CFP — 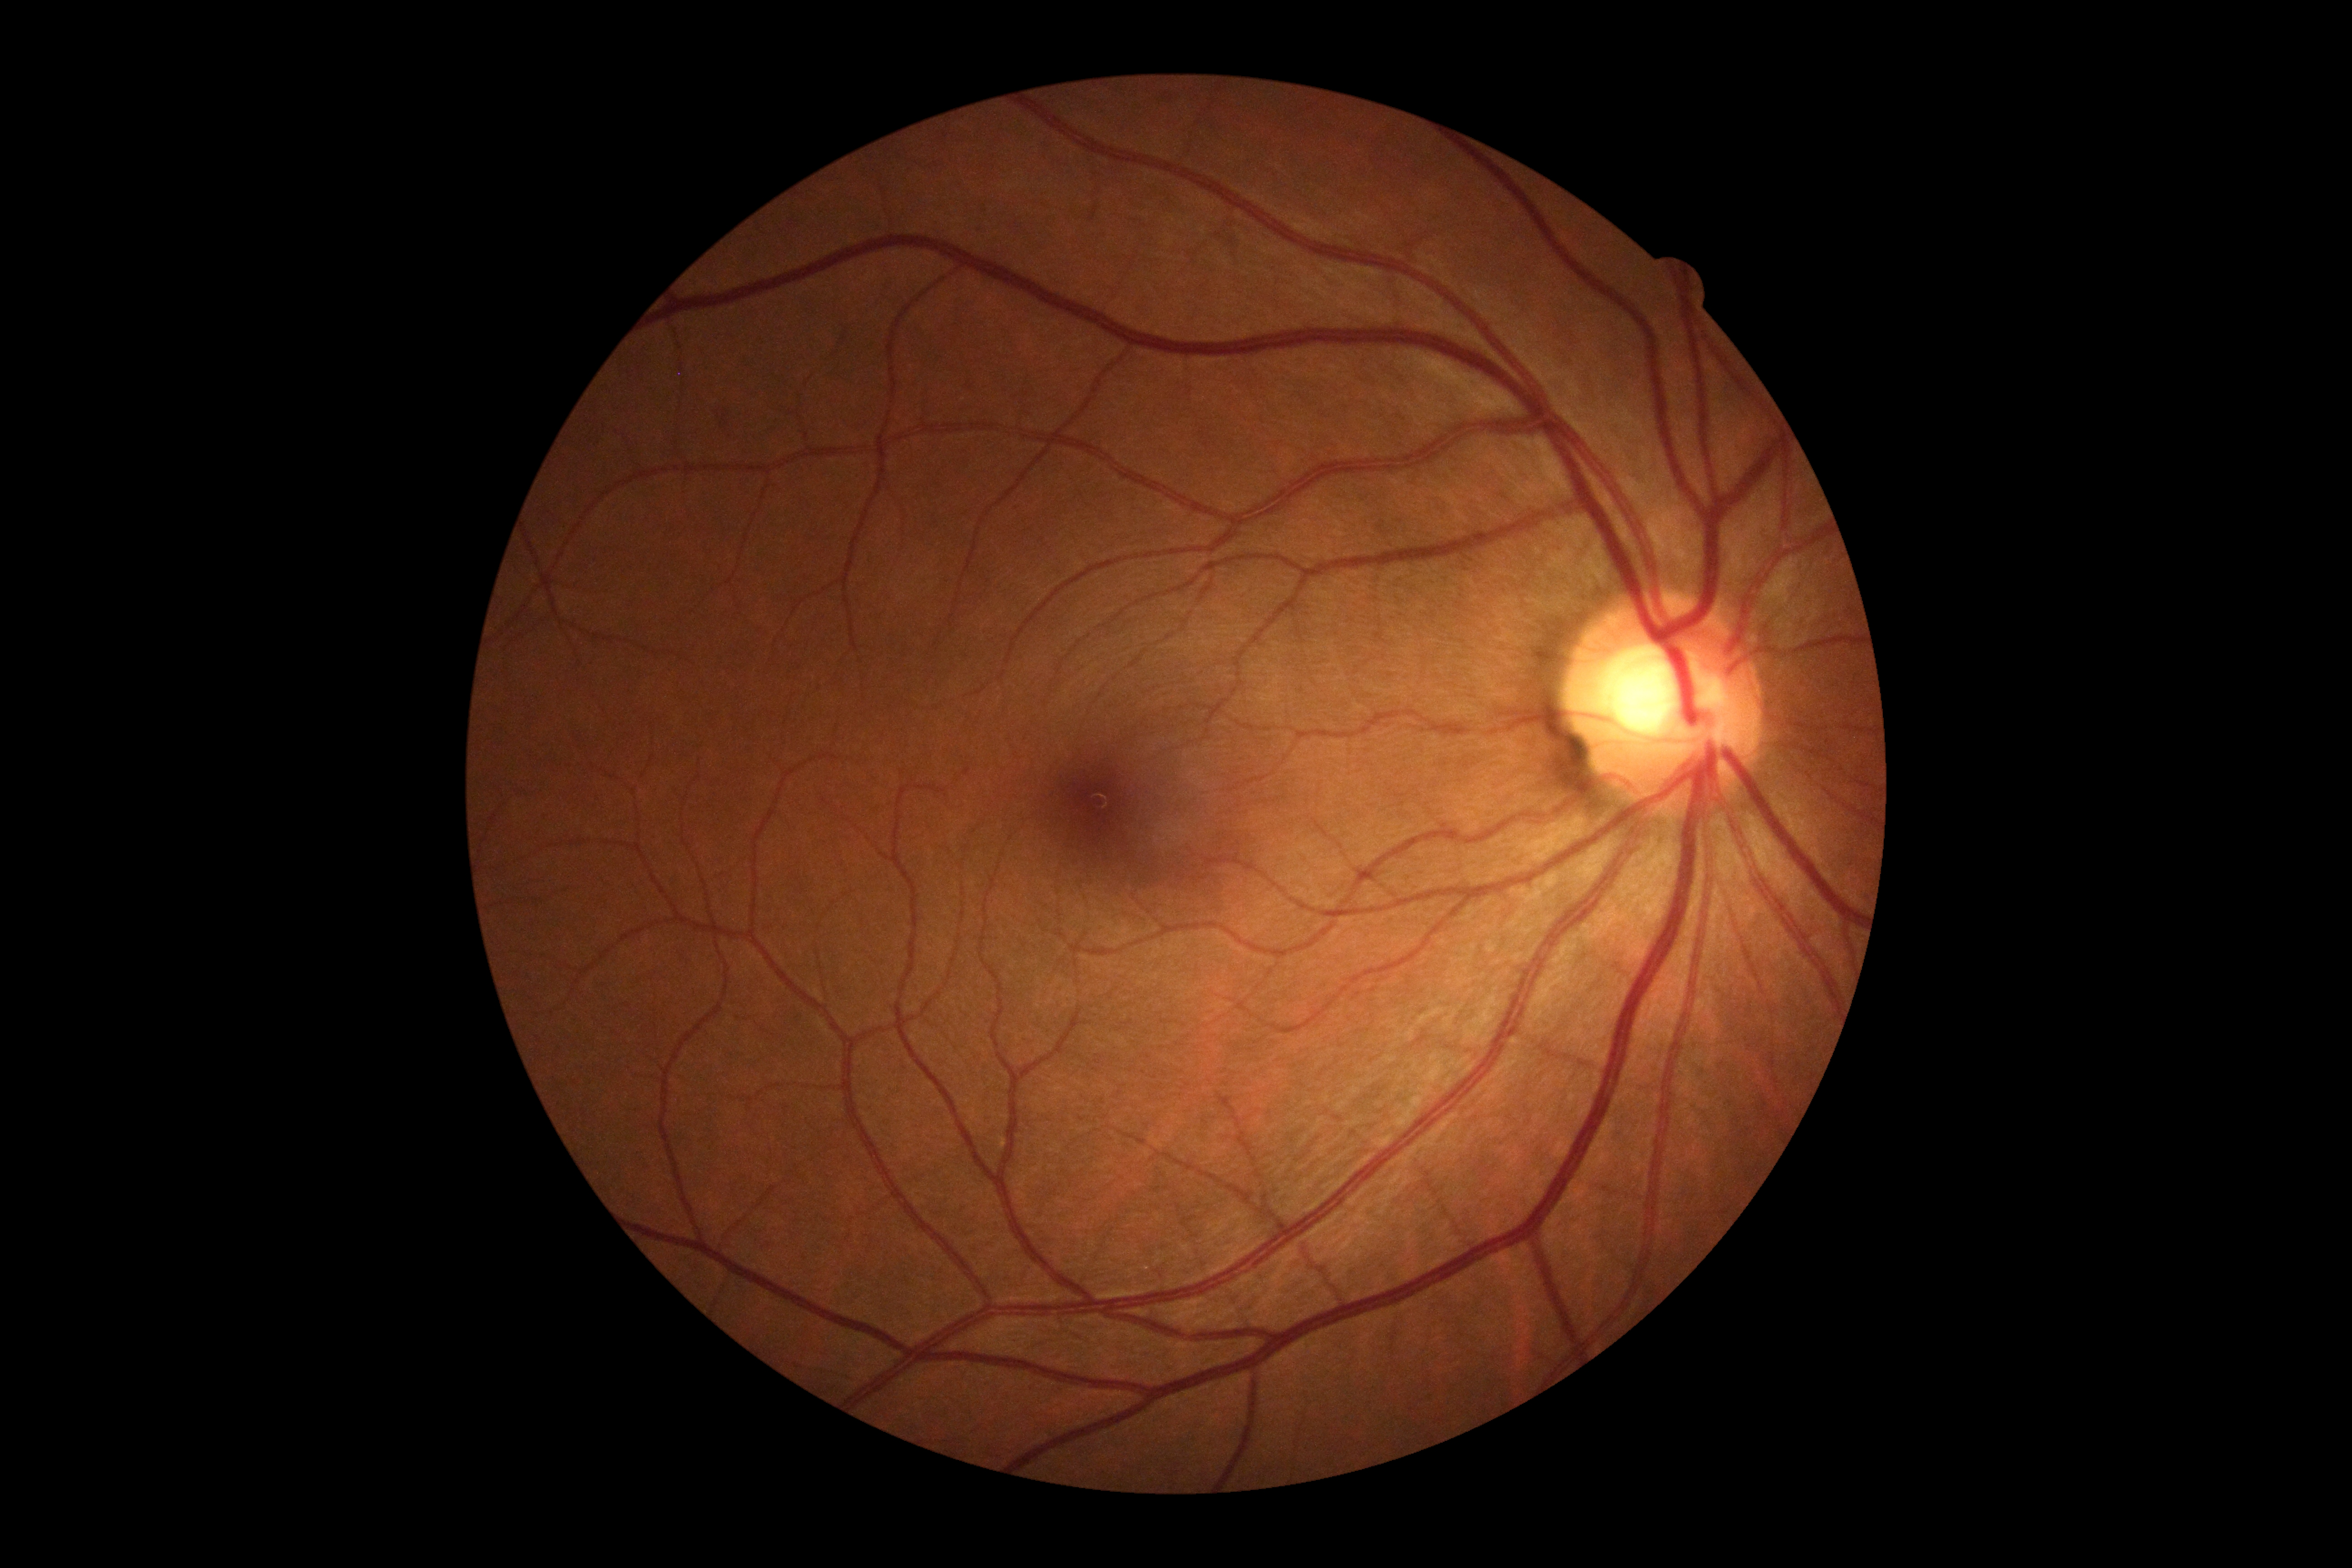

Diabetic retinopathy is 0/4.